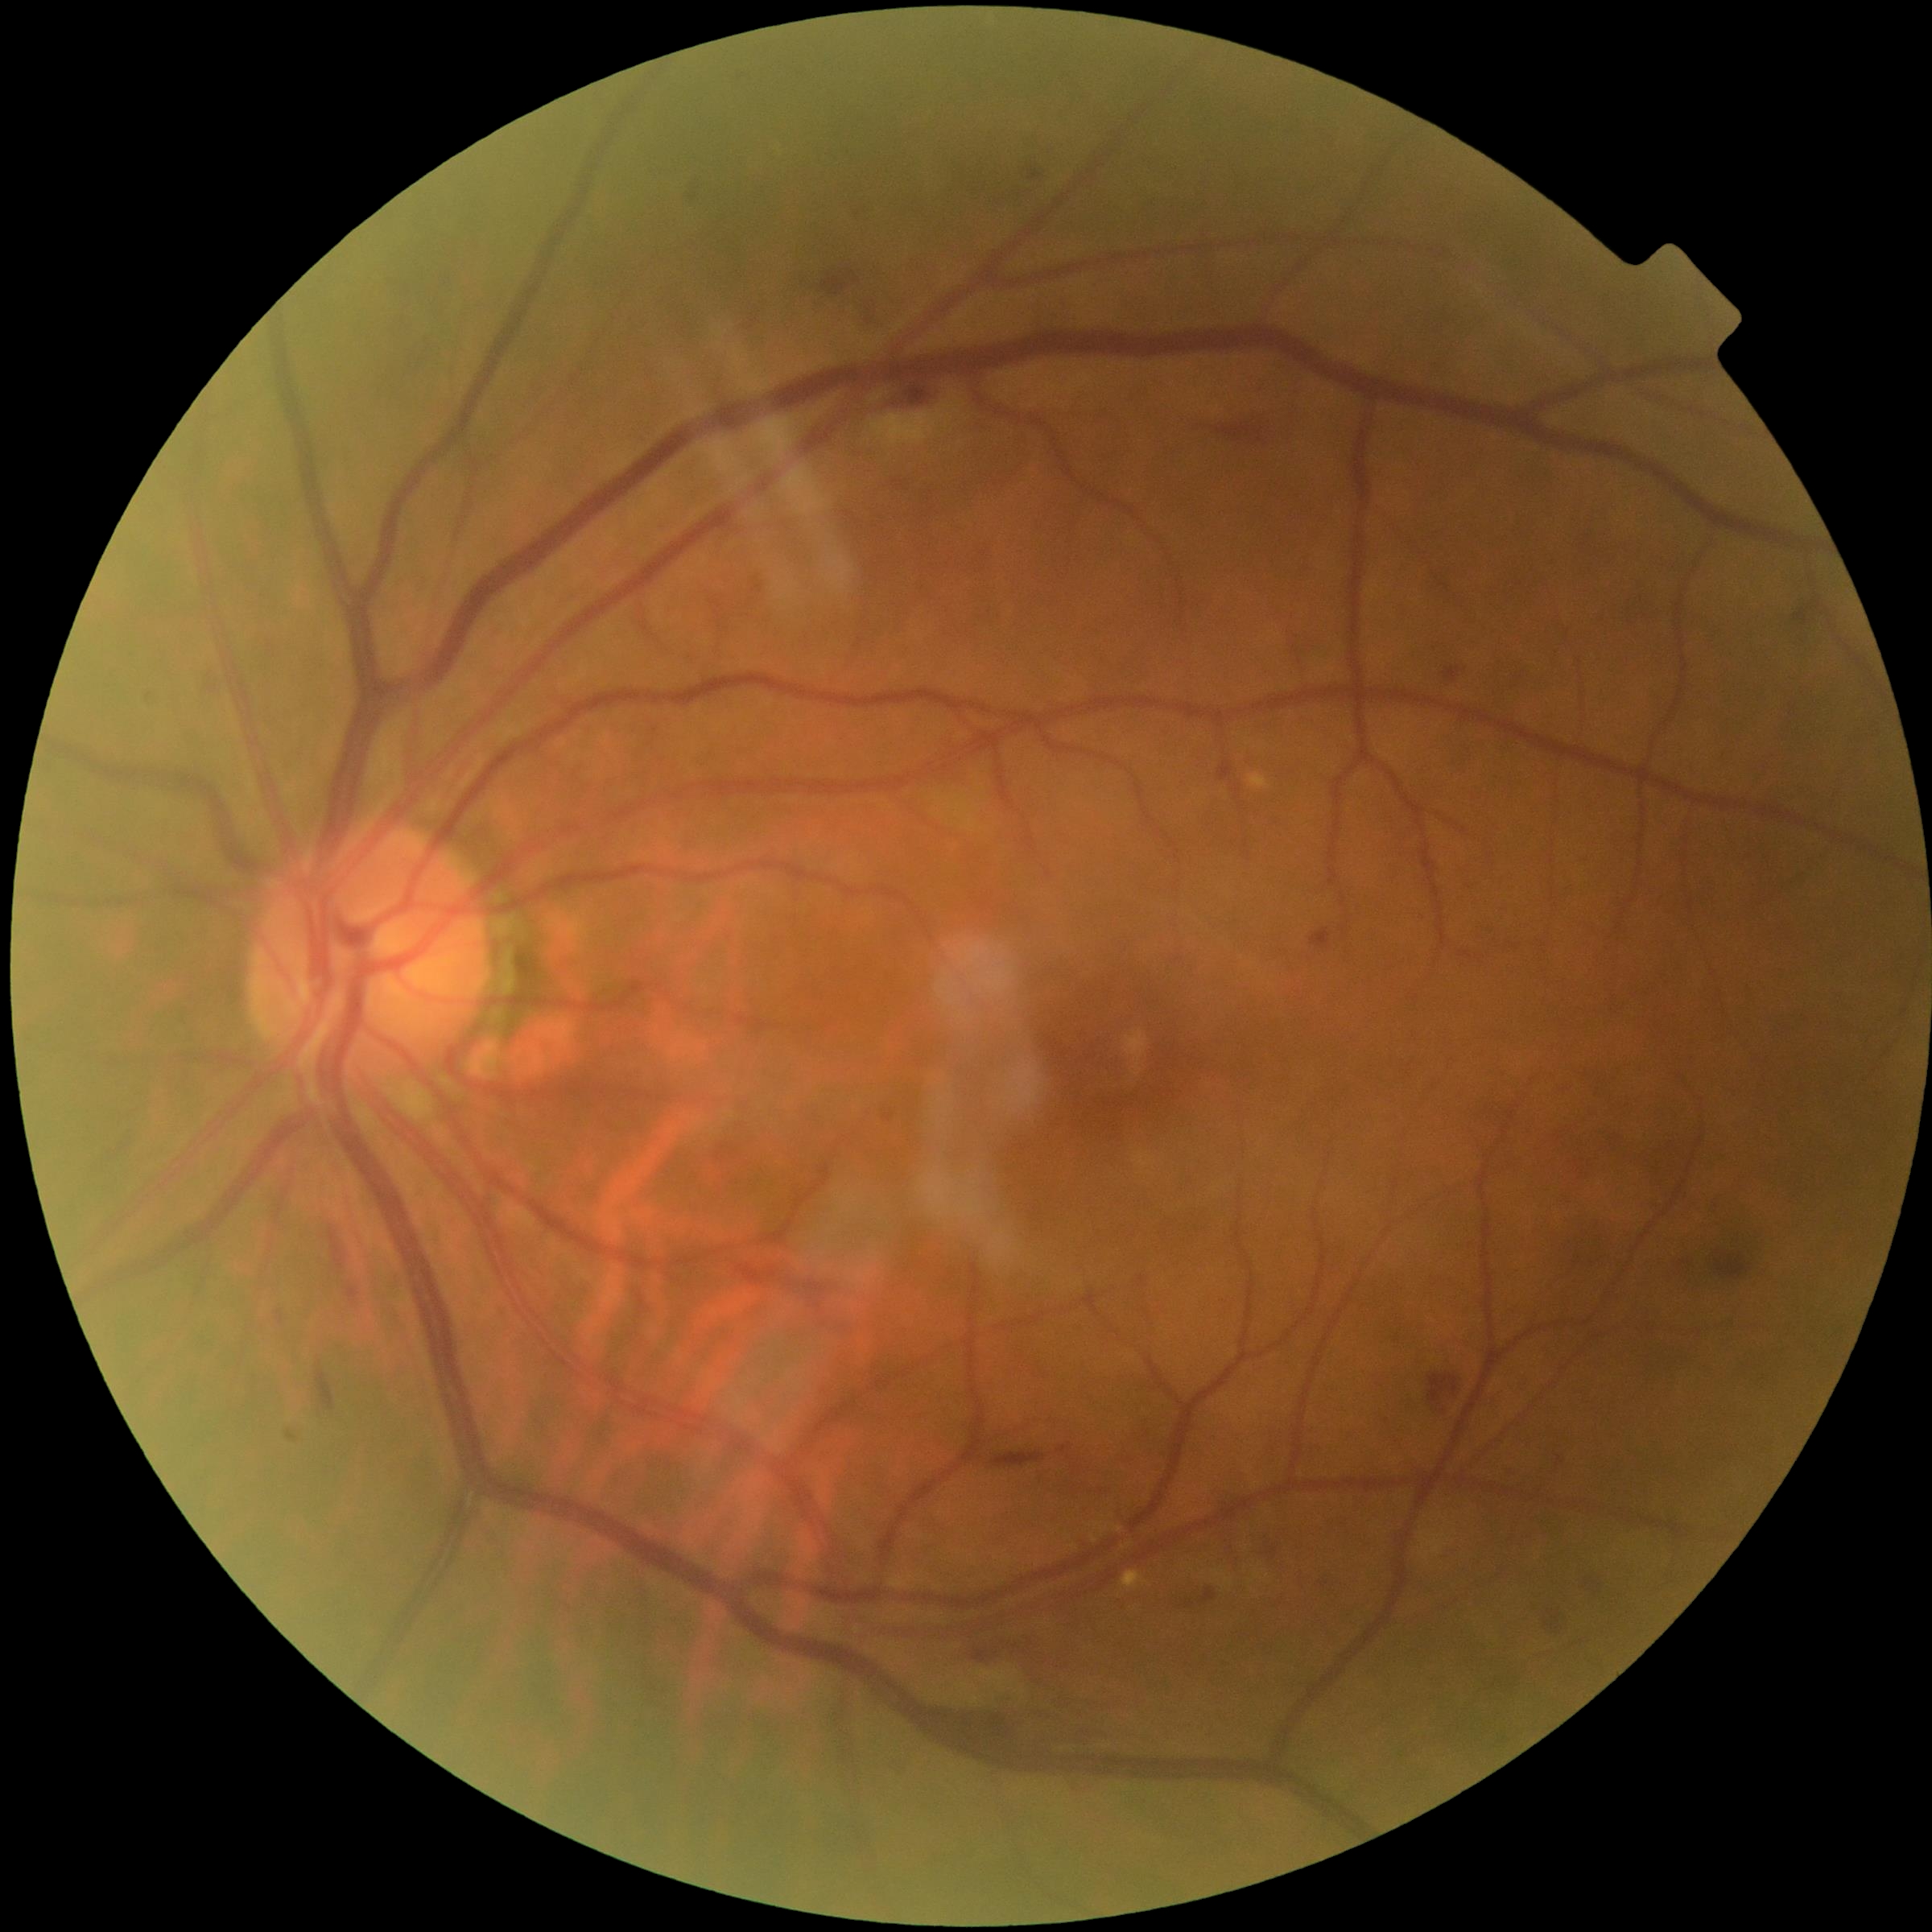 partial: true
dr_grade: 2
lesions:
  ex: []
  he:
    - <box>1702,1253,1751,1287</box>
    - <box>1541,1606,1571,1634</box>
    - <box>346,1287,360,1306</box>
    - <box>329,1229,346,1270</box>
    - <box>877,382,949,411</box>
    - <box>388,349,422,375</box>
    - <box>1060,1445,1071,1454</box>
    - <box>857,296,872,328</box>
    - <box>1018,163,1039,186</box>
    - <box>821,272,861,296</box>
    - <box>939,1713,1090,1748</box>
    - <box>996,188,1030,204</box>
    - <box>1176,1591,1223,1616</box>
  ma:
    - <box>1311,929,1332,949</box>
    - <box>1218,762,1234,782</box>
    - <box>1445,668,1459,683</box>
  se:
    - <box>872,399,960,450</box>
    - <box>1203,1568,1265,1597</box>
    - <box>1417,1533,1443,1559</box>
    - <box>939,1672,1046,1706</box>